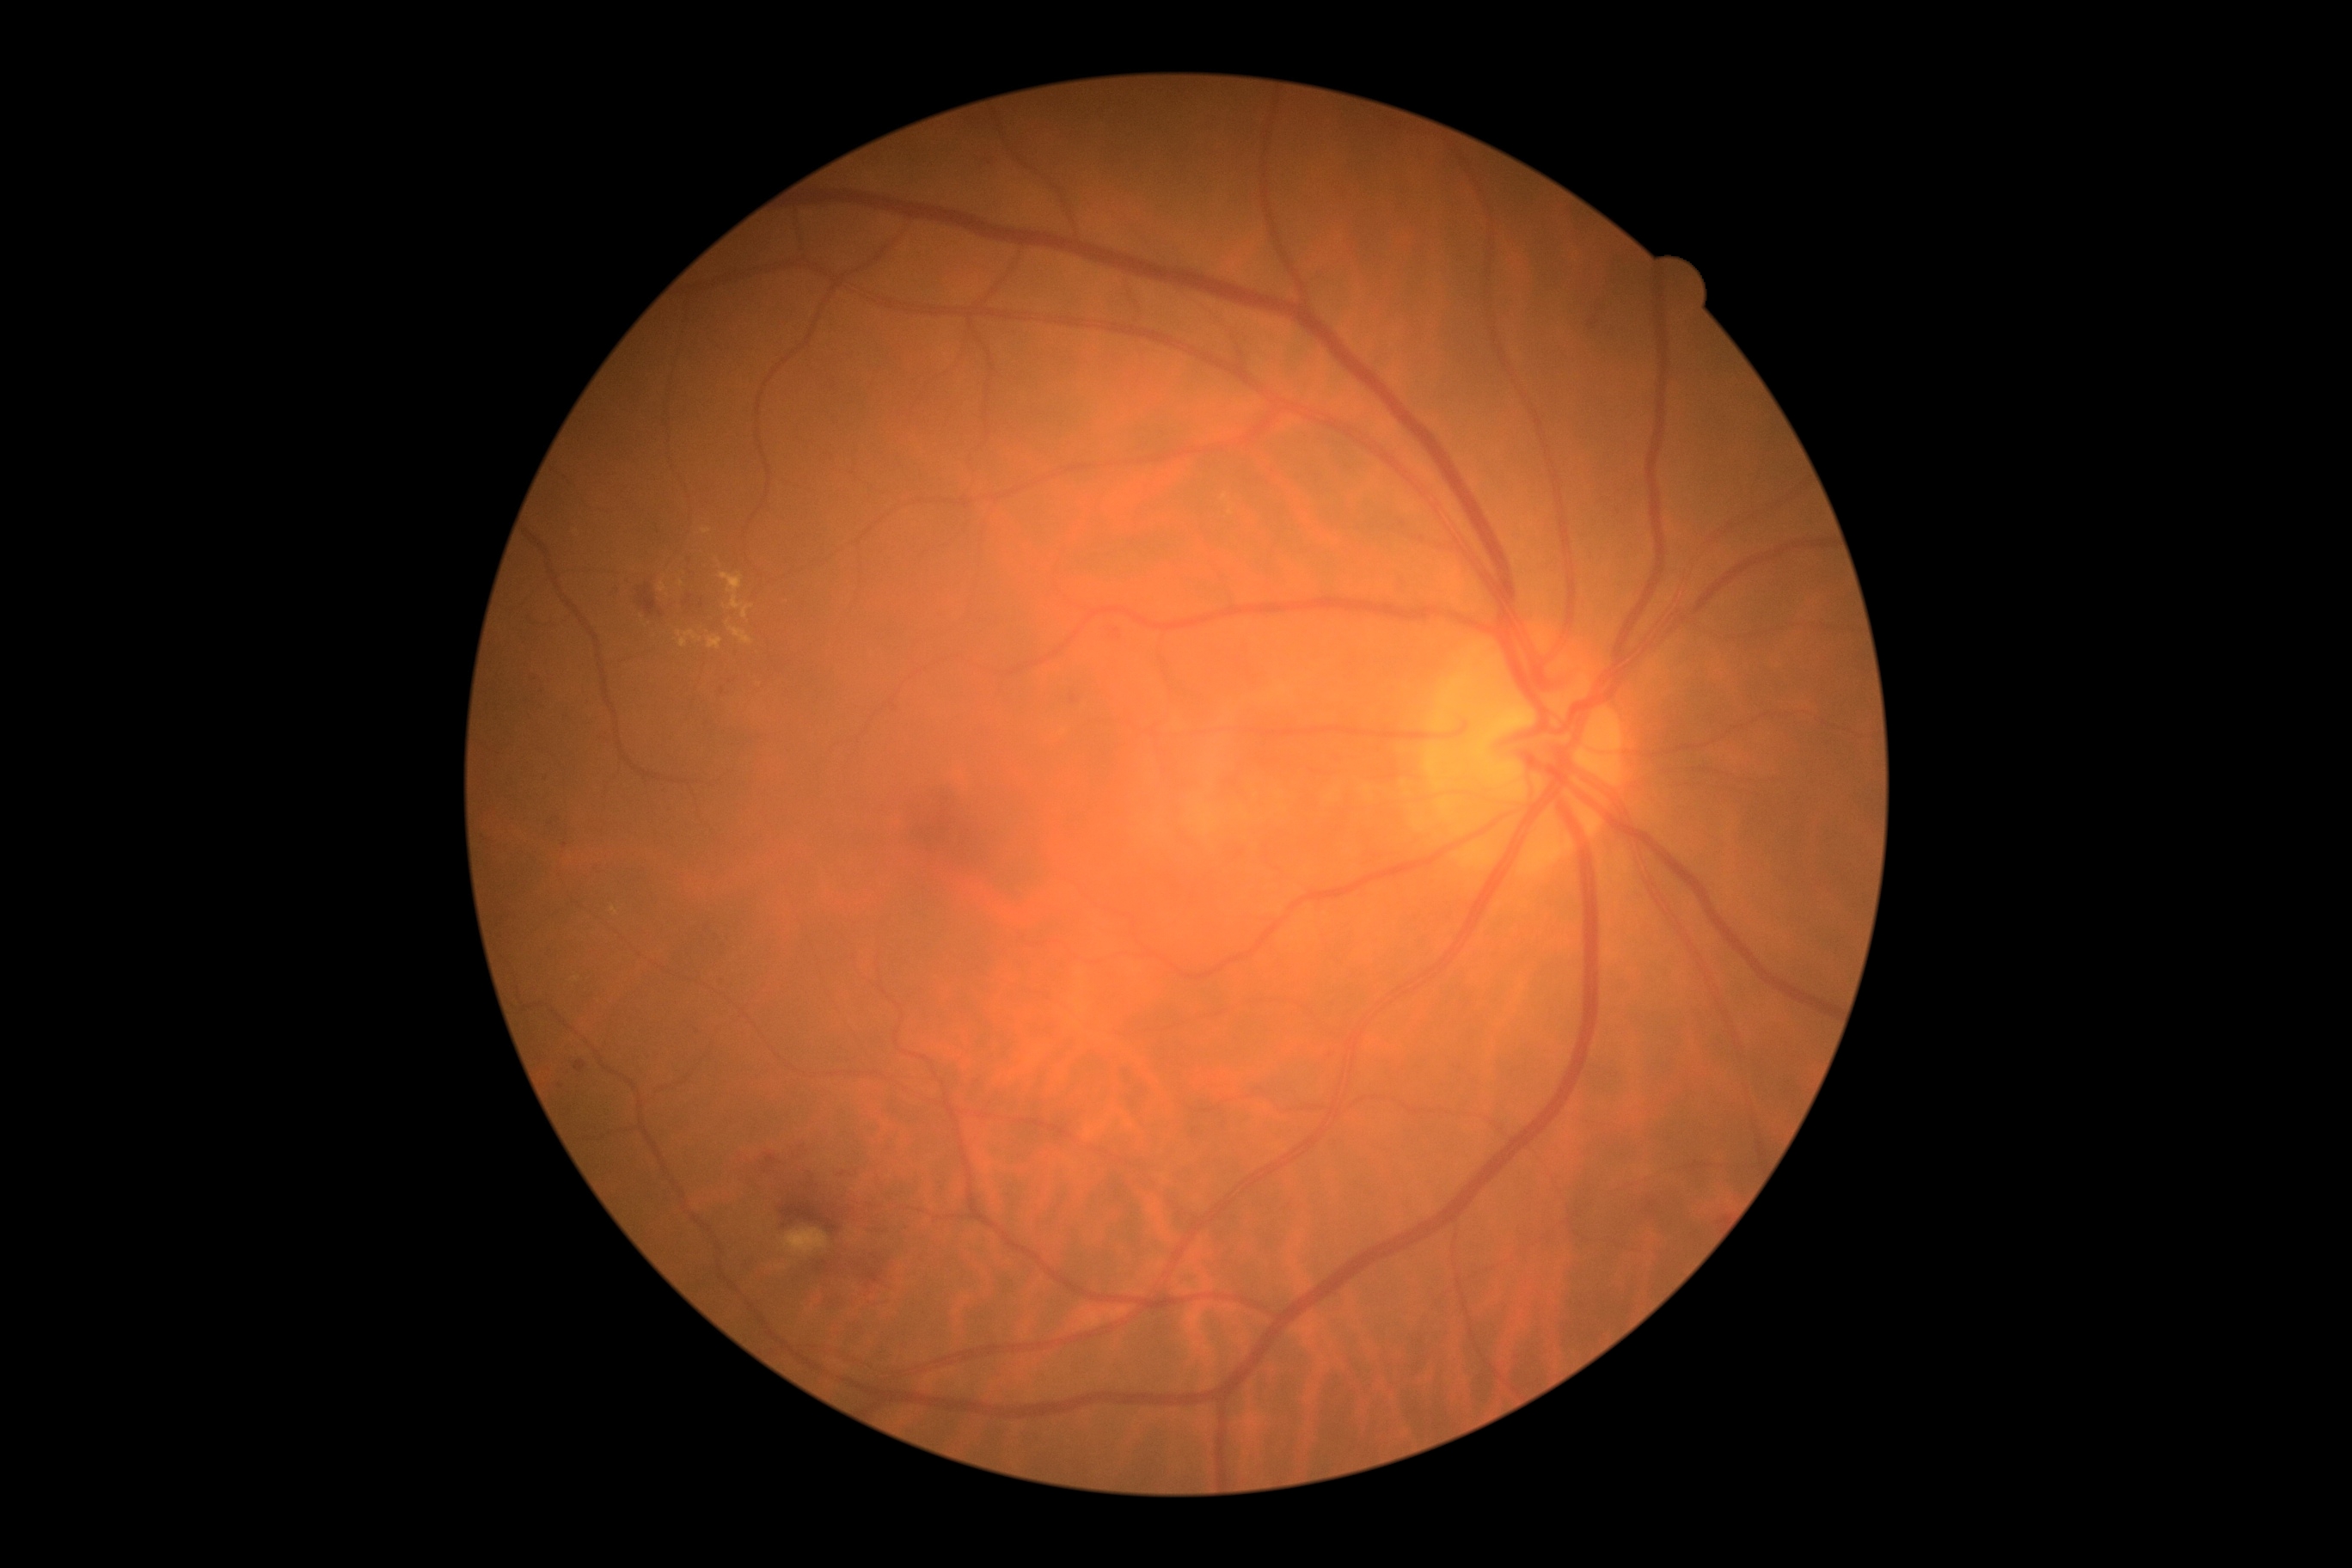 DR grade = 2 (moderate NPDR).